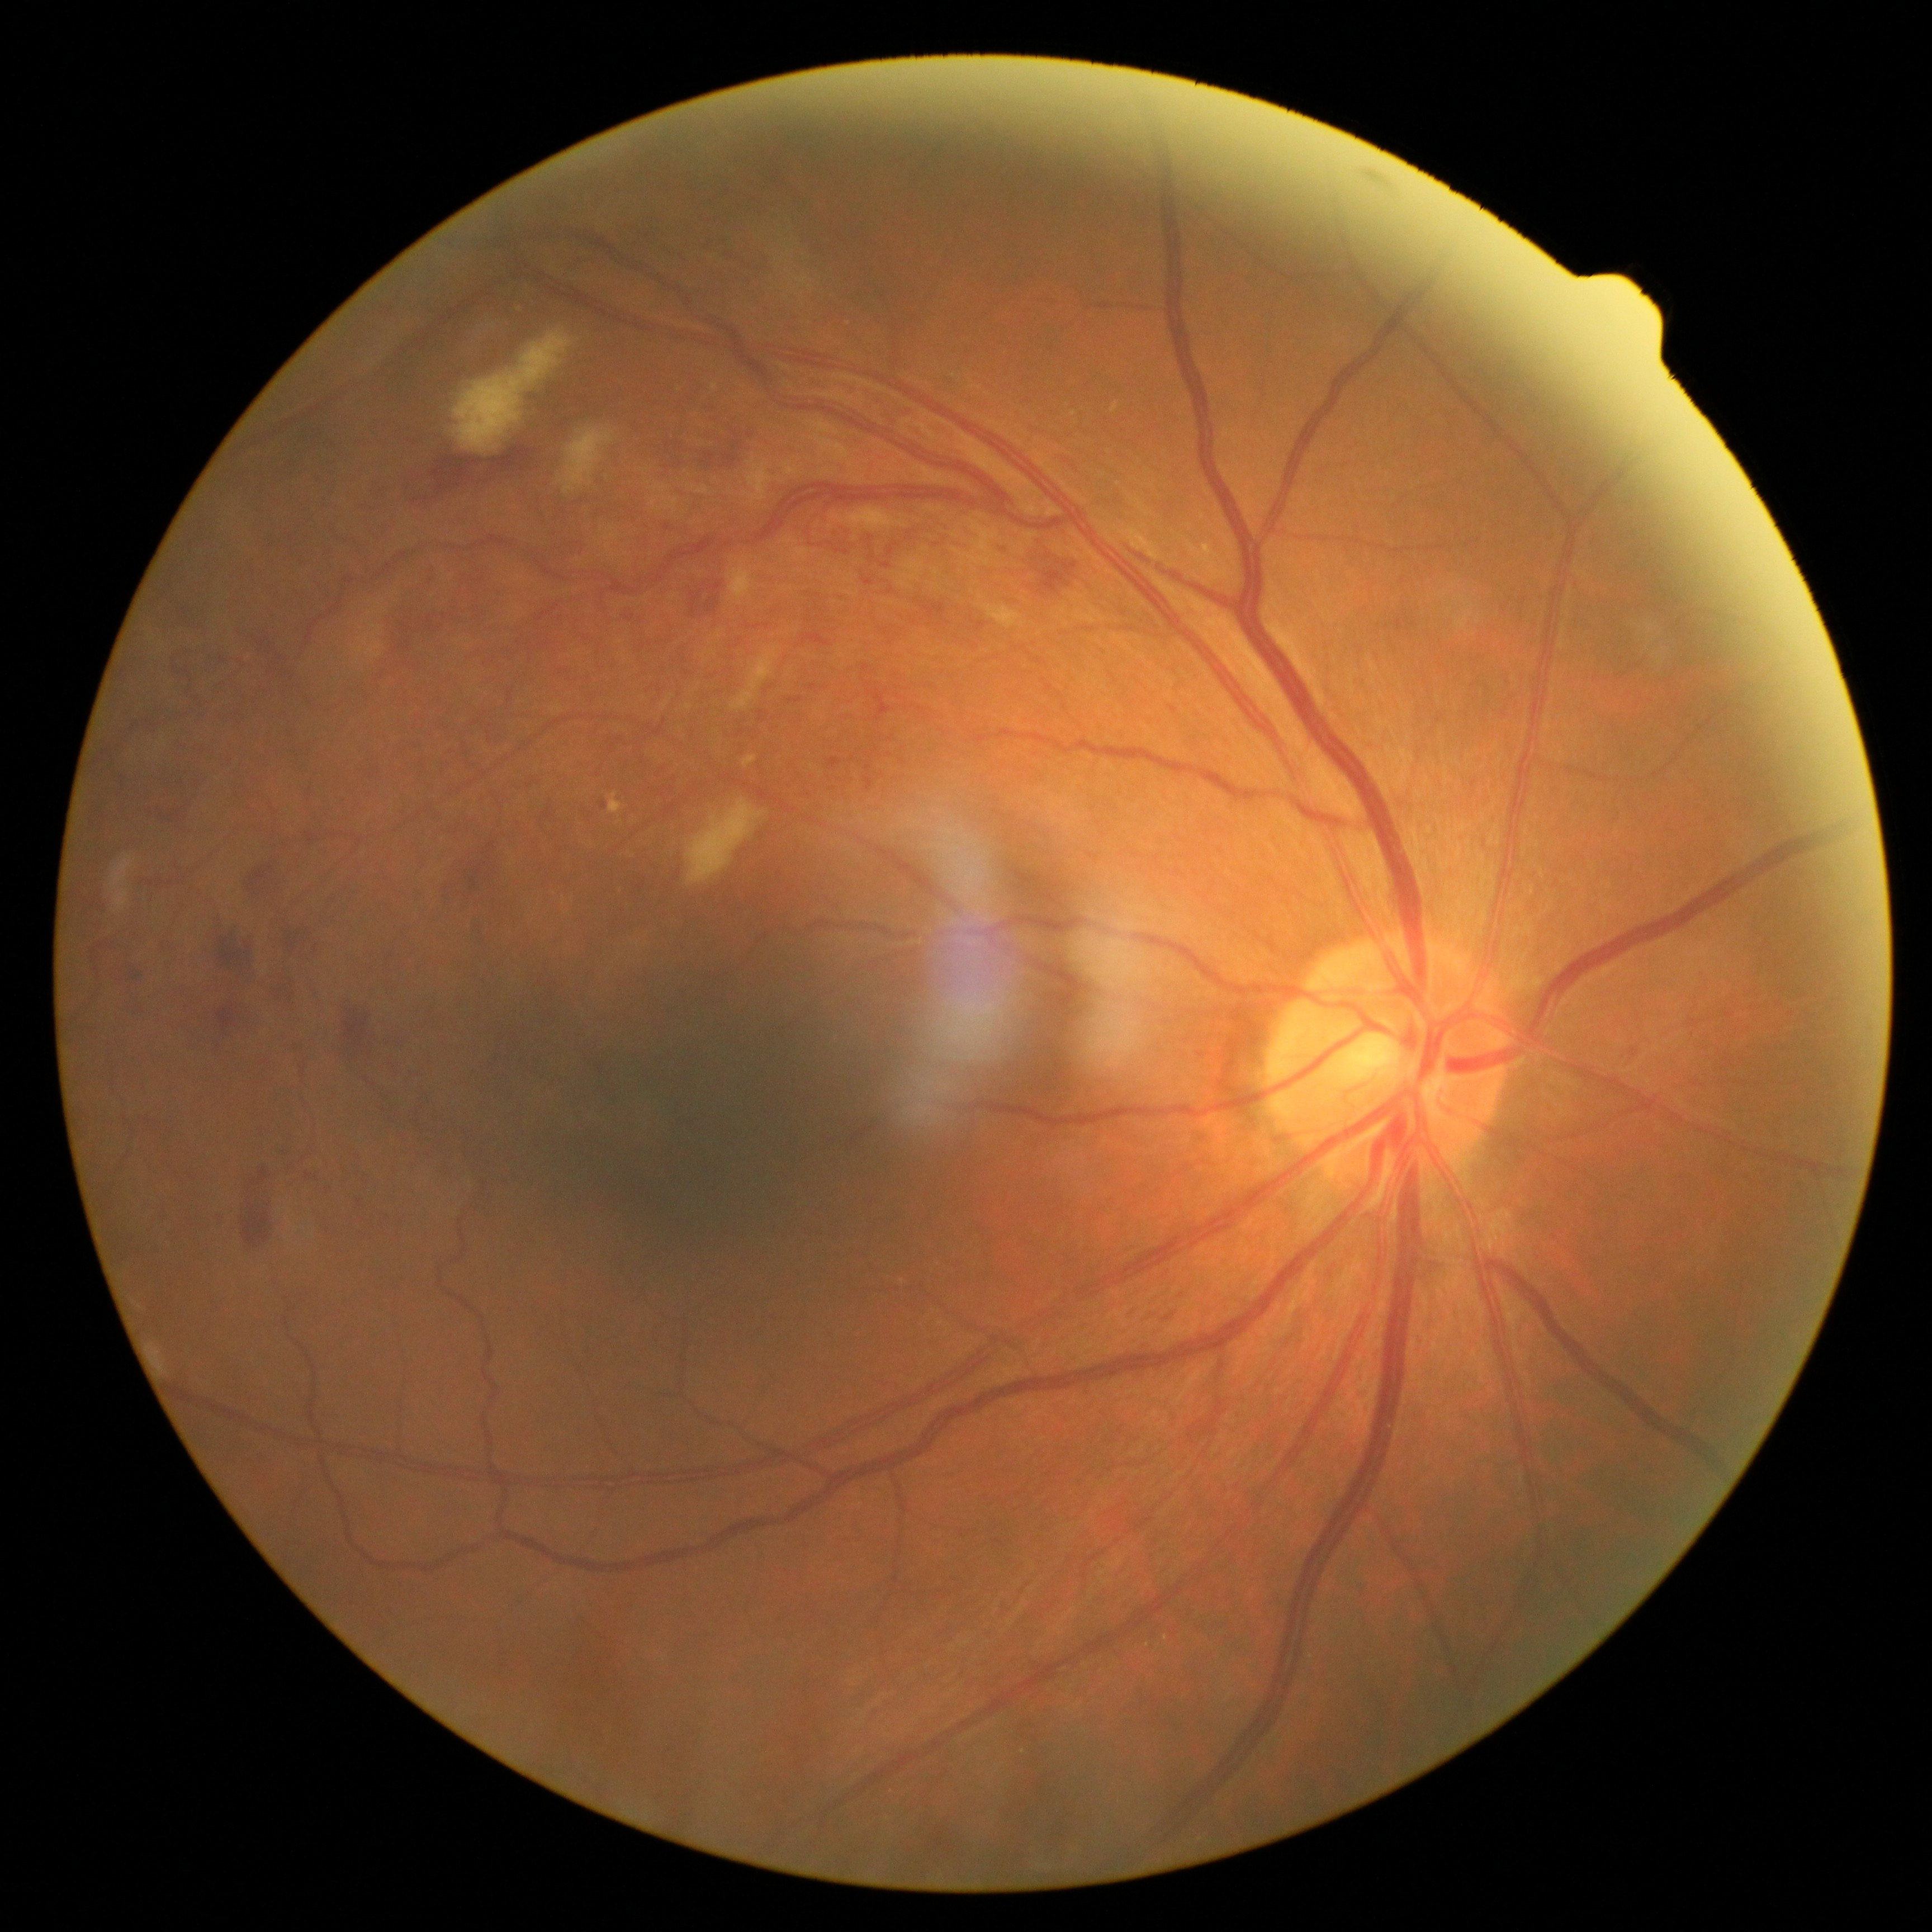

DR stage is grade 3.